Retinal fundus photograph.
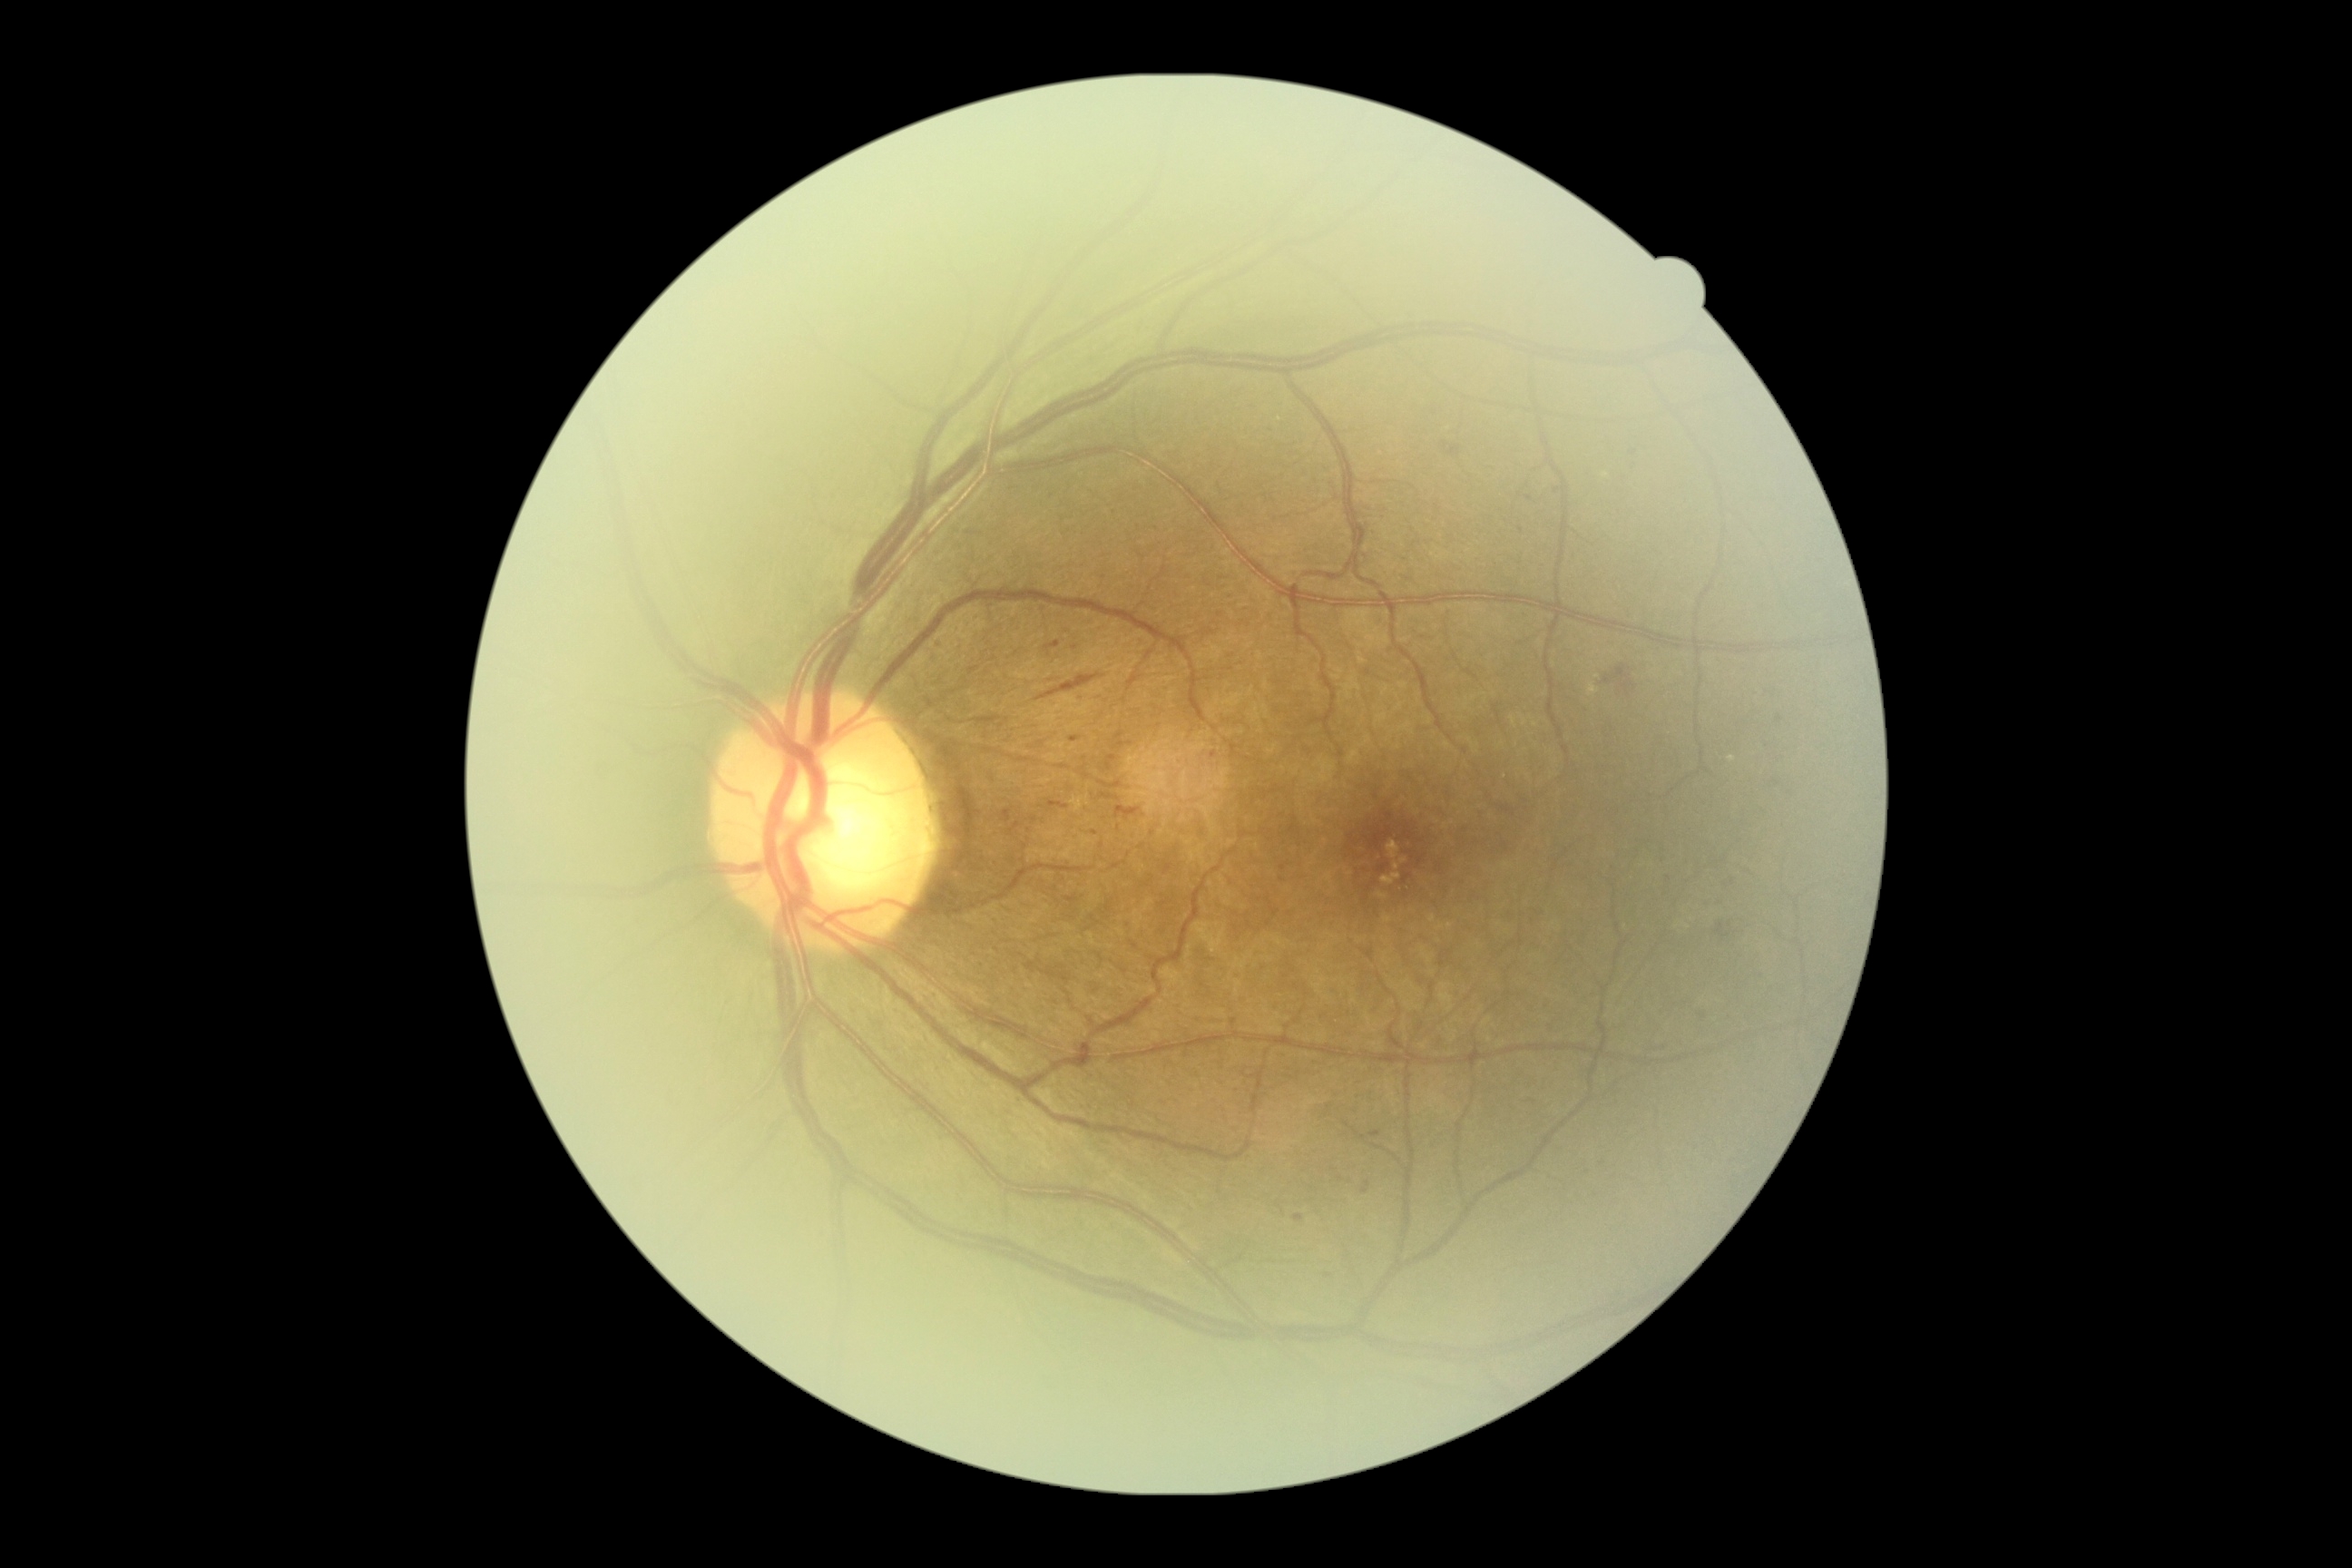

Diabetic retinopathy severity is grade 2 (moderate NPDR).